Clarity RetCam 3, 130° FOV; wide-field contact fundus photograph of an infant; 640 x 480 pixels — 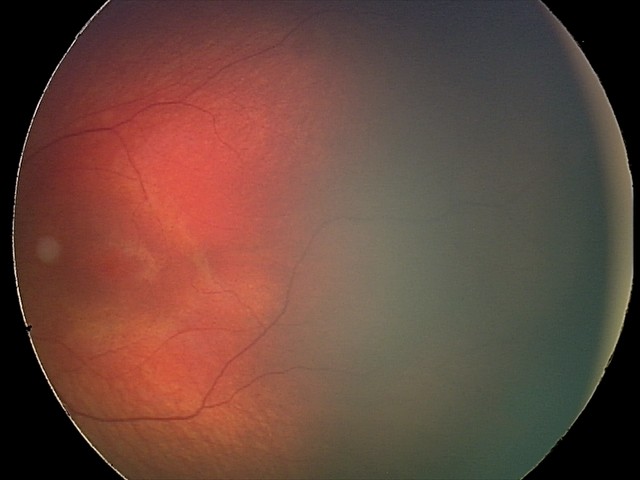
Finding = retinal hemorrhages